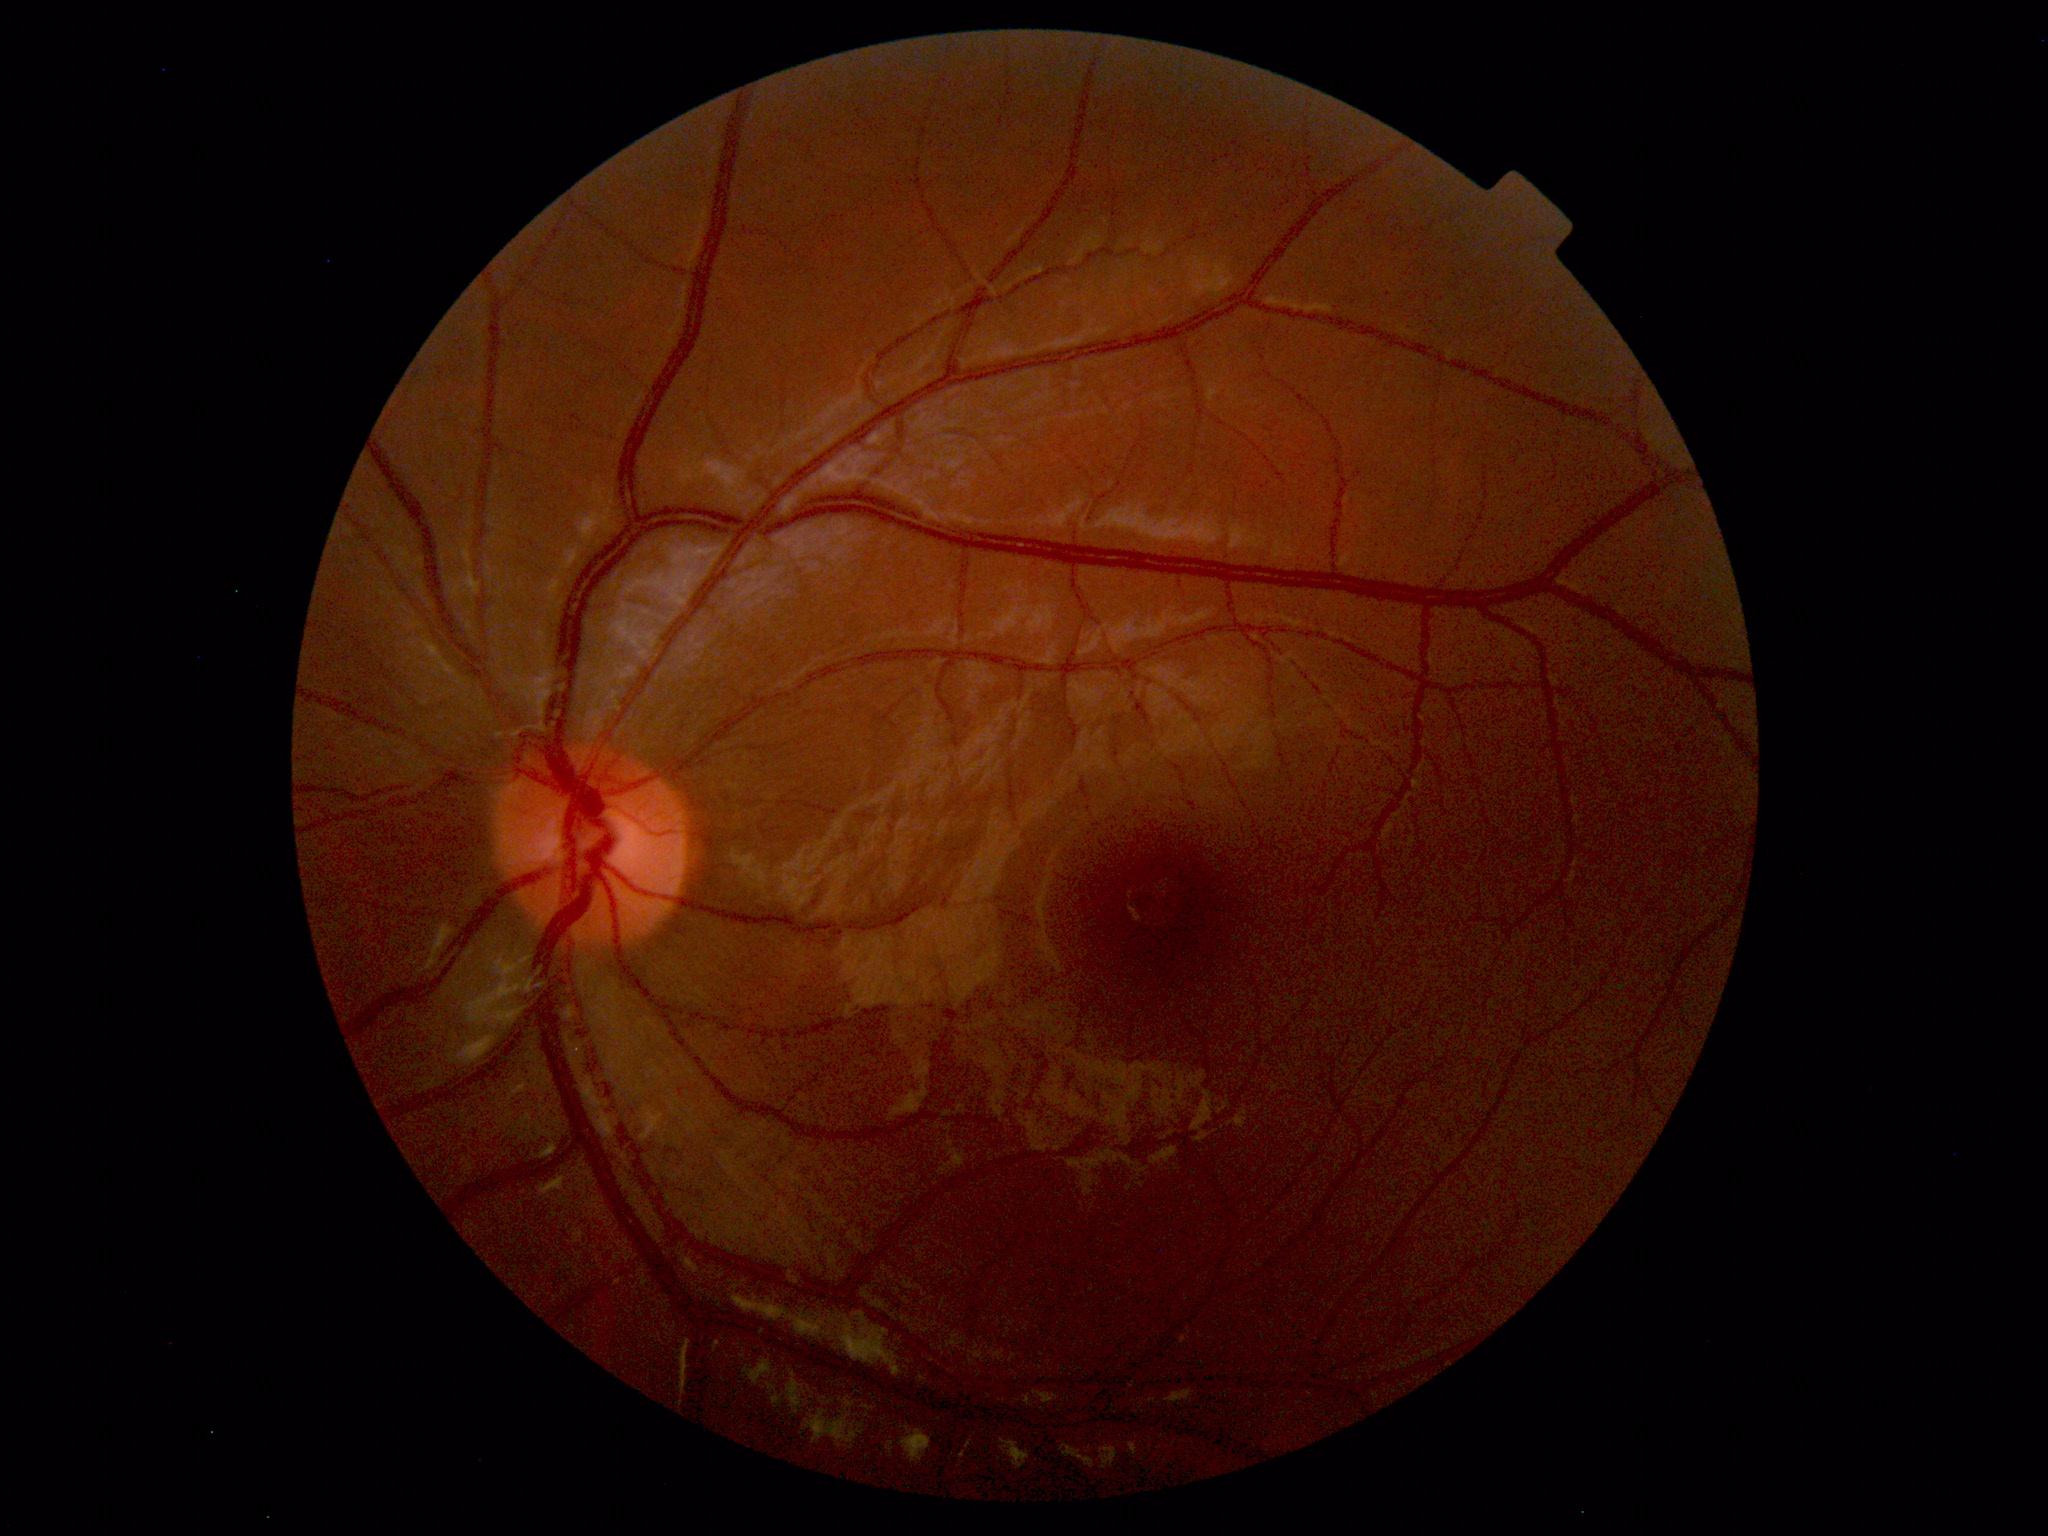
No retinal pathology identified.